Color fundus image
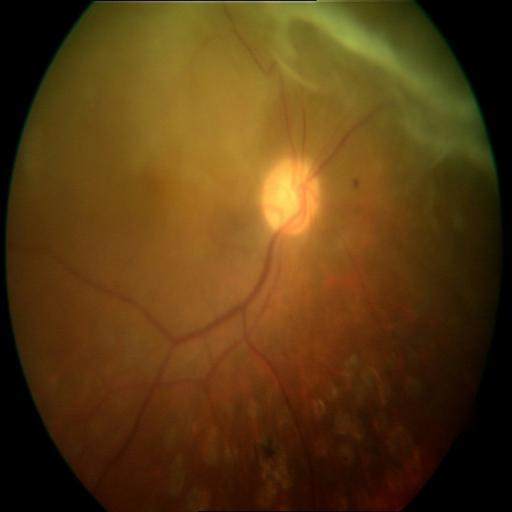

Showing retinal traction.